Infant wide-field fundus photograph:
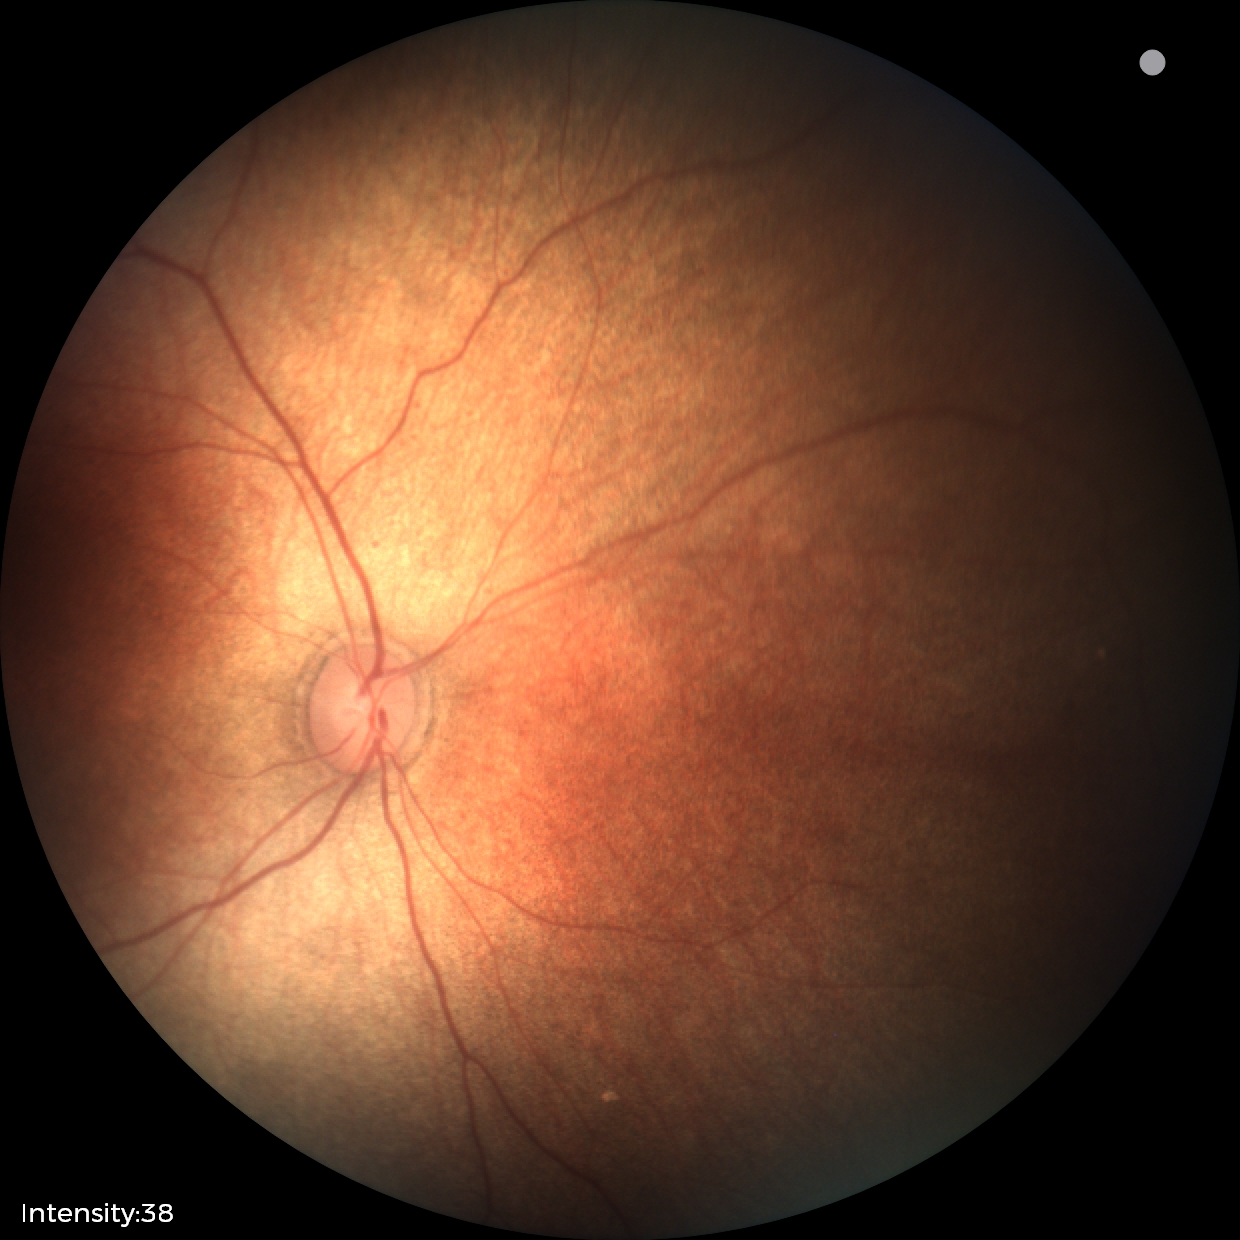 Physiological retinal appearance for postconceptual age.